Retinal fundus photograph — 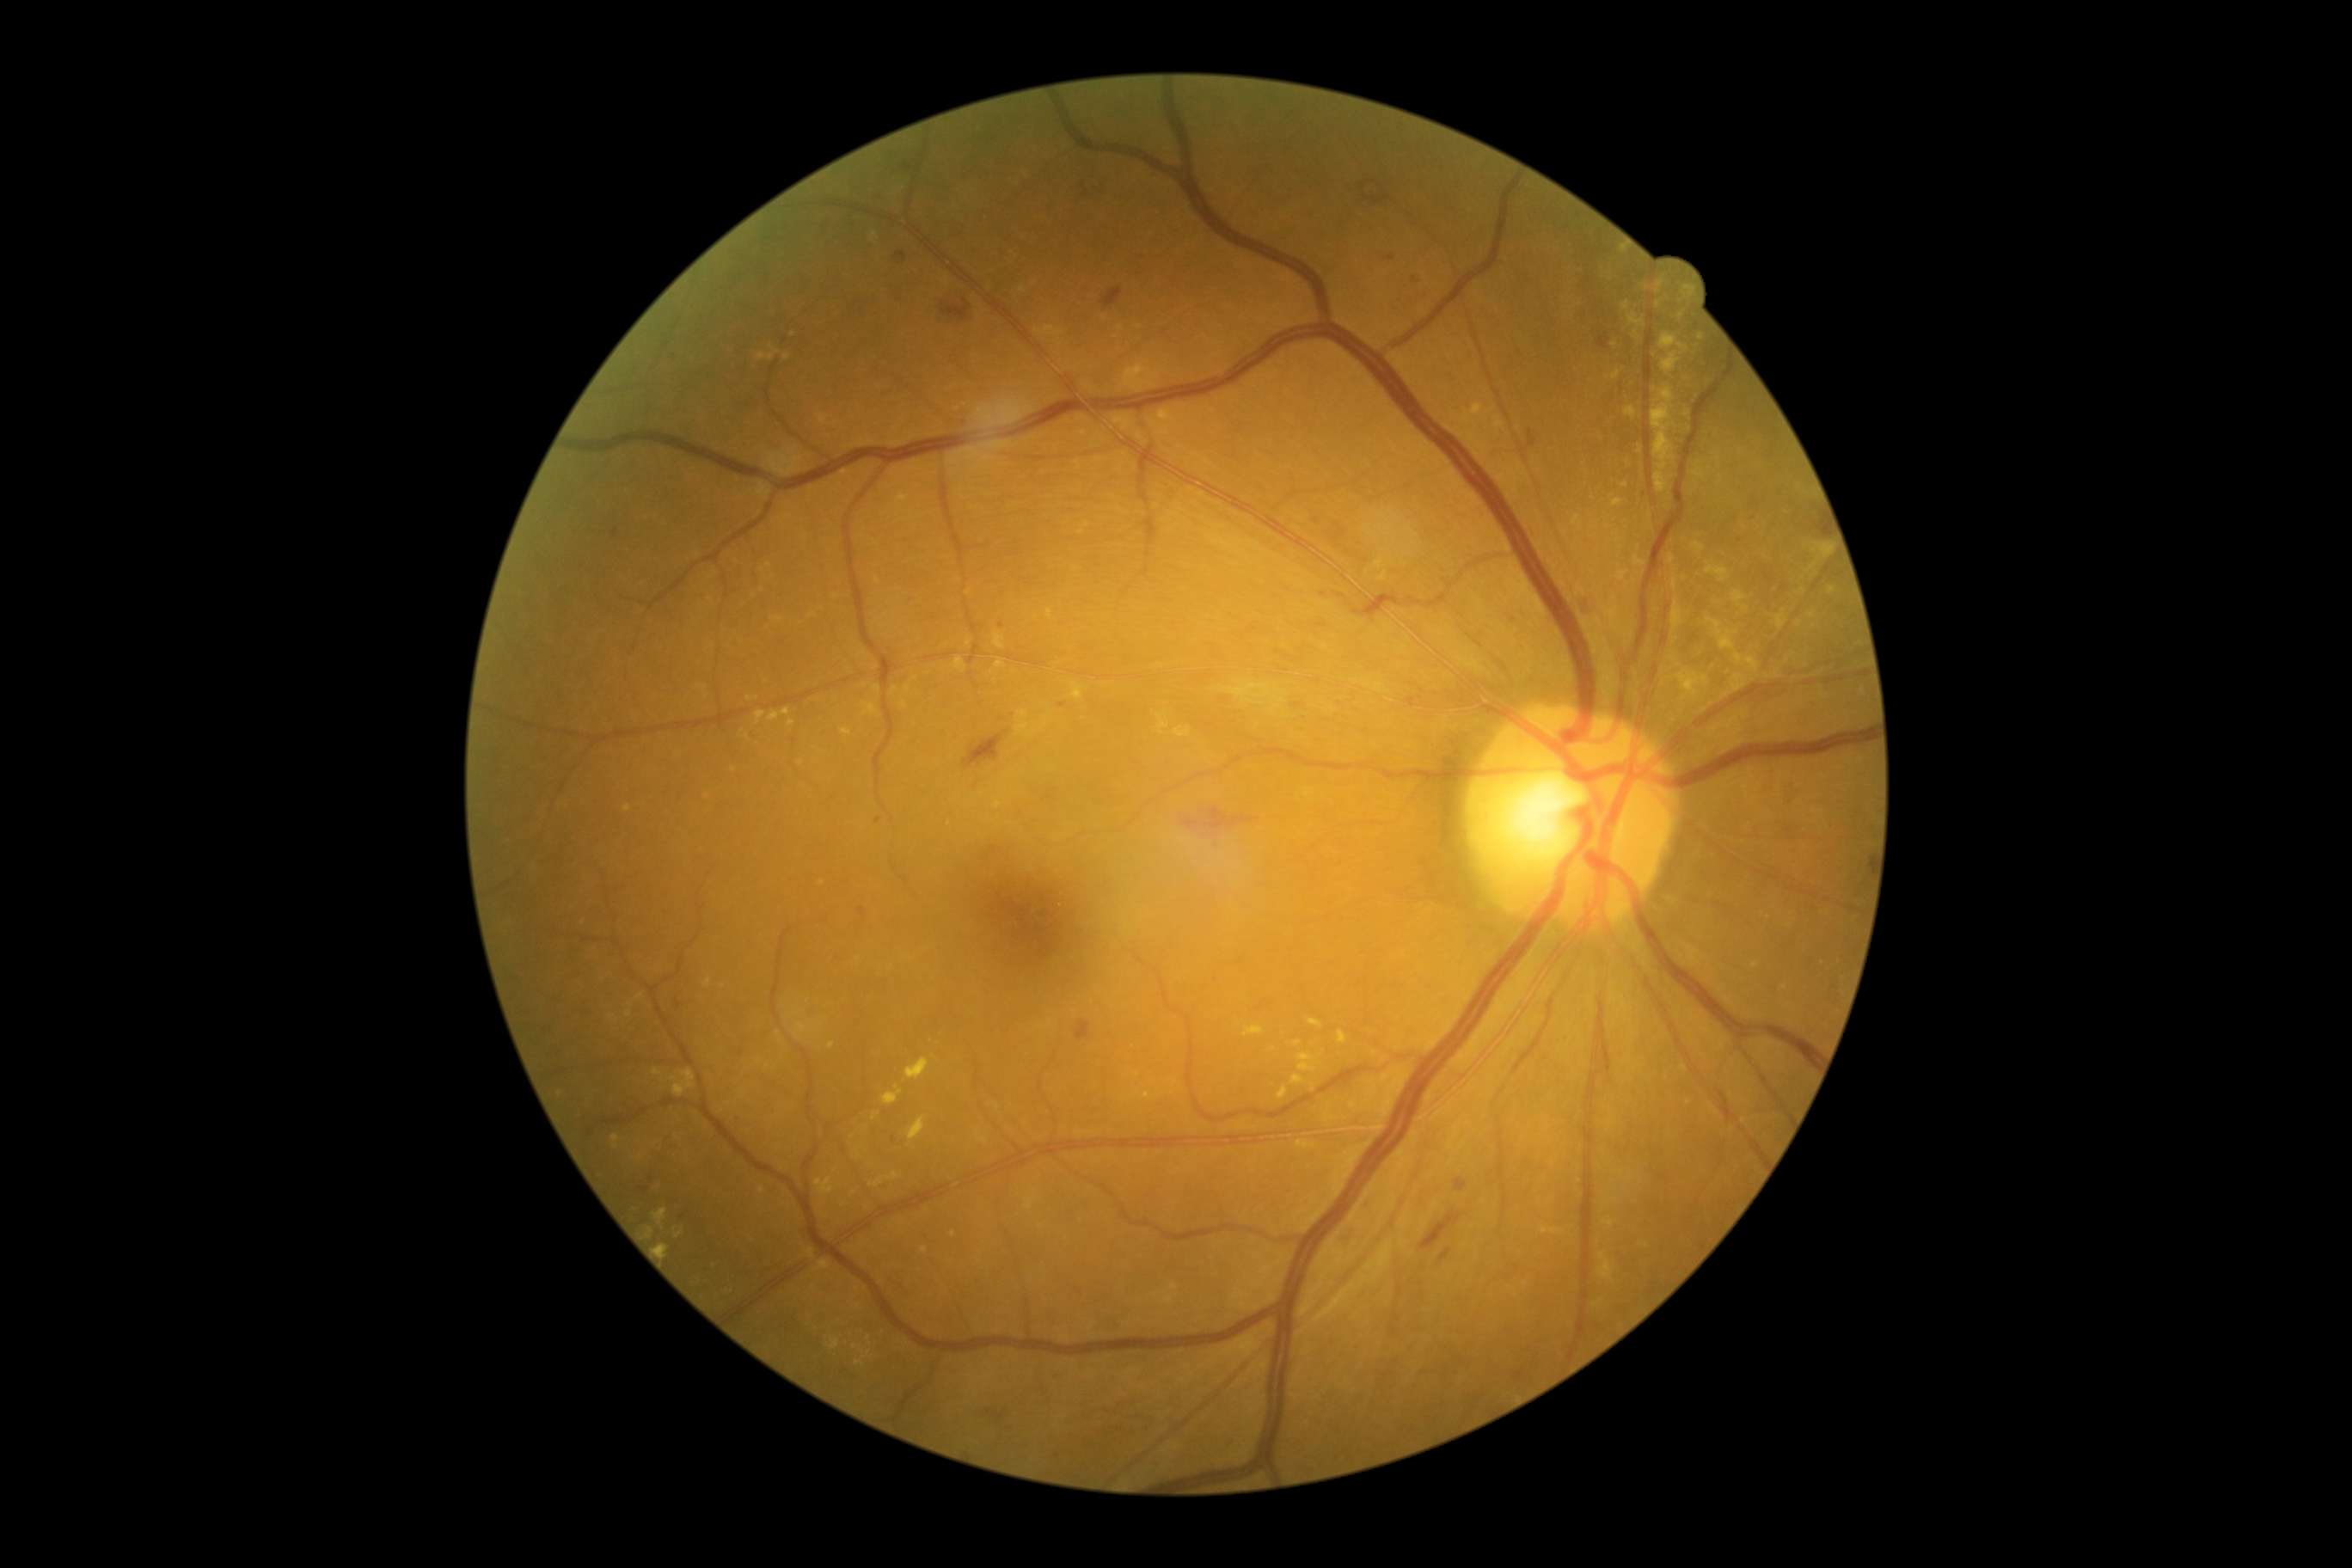
Diabetic retinopathy (DR): grade 2 (moderate NPDR); non-proliferative diabetic retinopathy
Selected lesions:
hard exudates (EXs) (subset): bbox=(907, 1117, 928, 1146) | bbox=(1158, 408, 1177, 424) | bbox=(873, 1113, 881, 1120) | bbox=(1072, 683, 1082, 701) | bbox=(1662, 352, 1681, 377) | bbox=(1541, 1228, 1564, 1235) | bbox=(852, 1344, 864, 1354) | bbox=(842, 728, 852, 737) | bbox=(1694, 469, 1705, 479) | bbox=(826, 1337, 842, 1351)
Additional small EXs near [707, 697] | [1701, 337] | [895, 690] | [786, 358] | [969, 643] | [1786, 662] | [1699, 463] | [747, 737]